Posterior pole photograph; DR severity per modified Davis staging; nonmydriatic fundus photograph
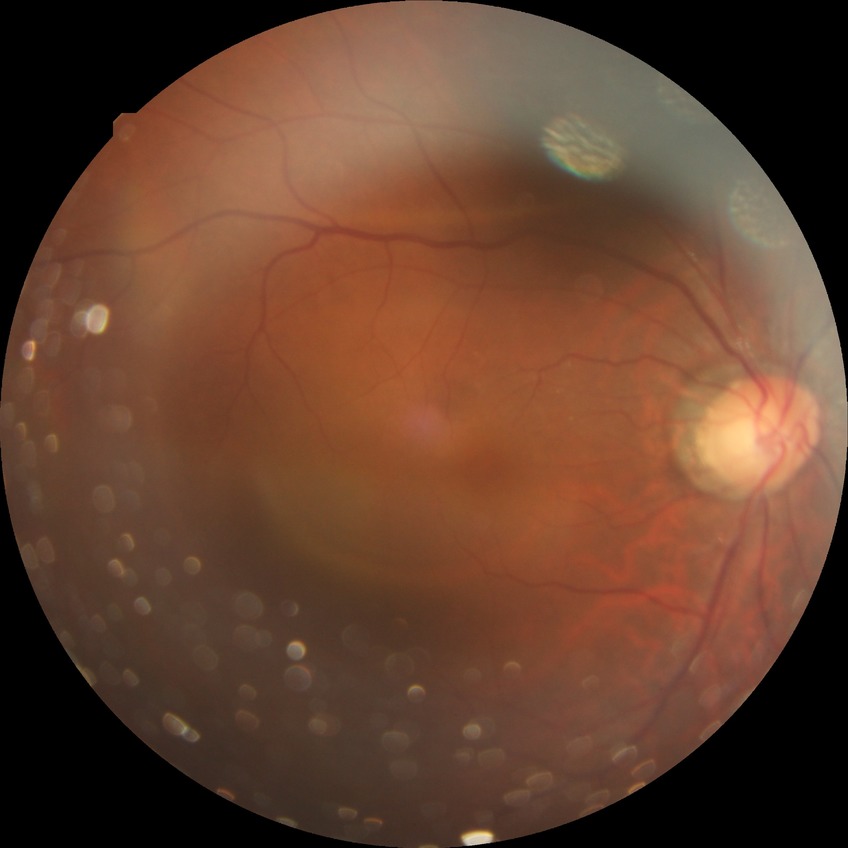

  davis_grade: NDR
  dr_impression: no signs of DR